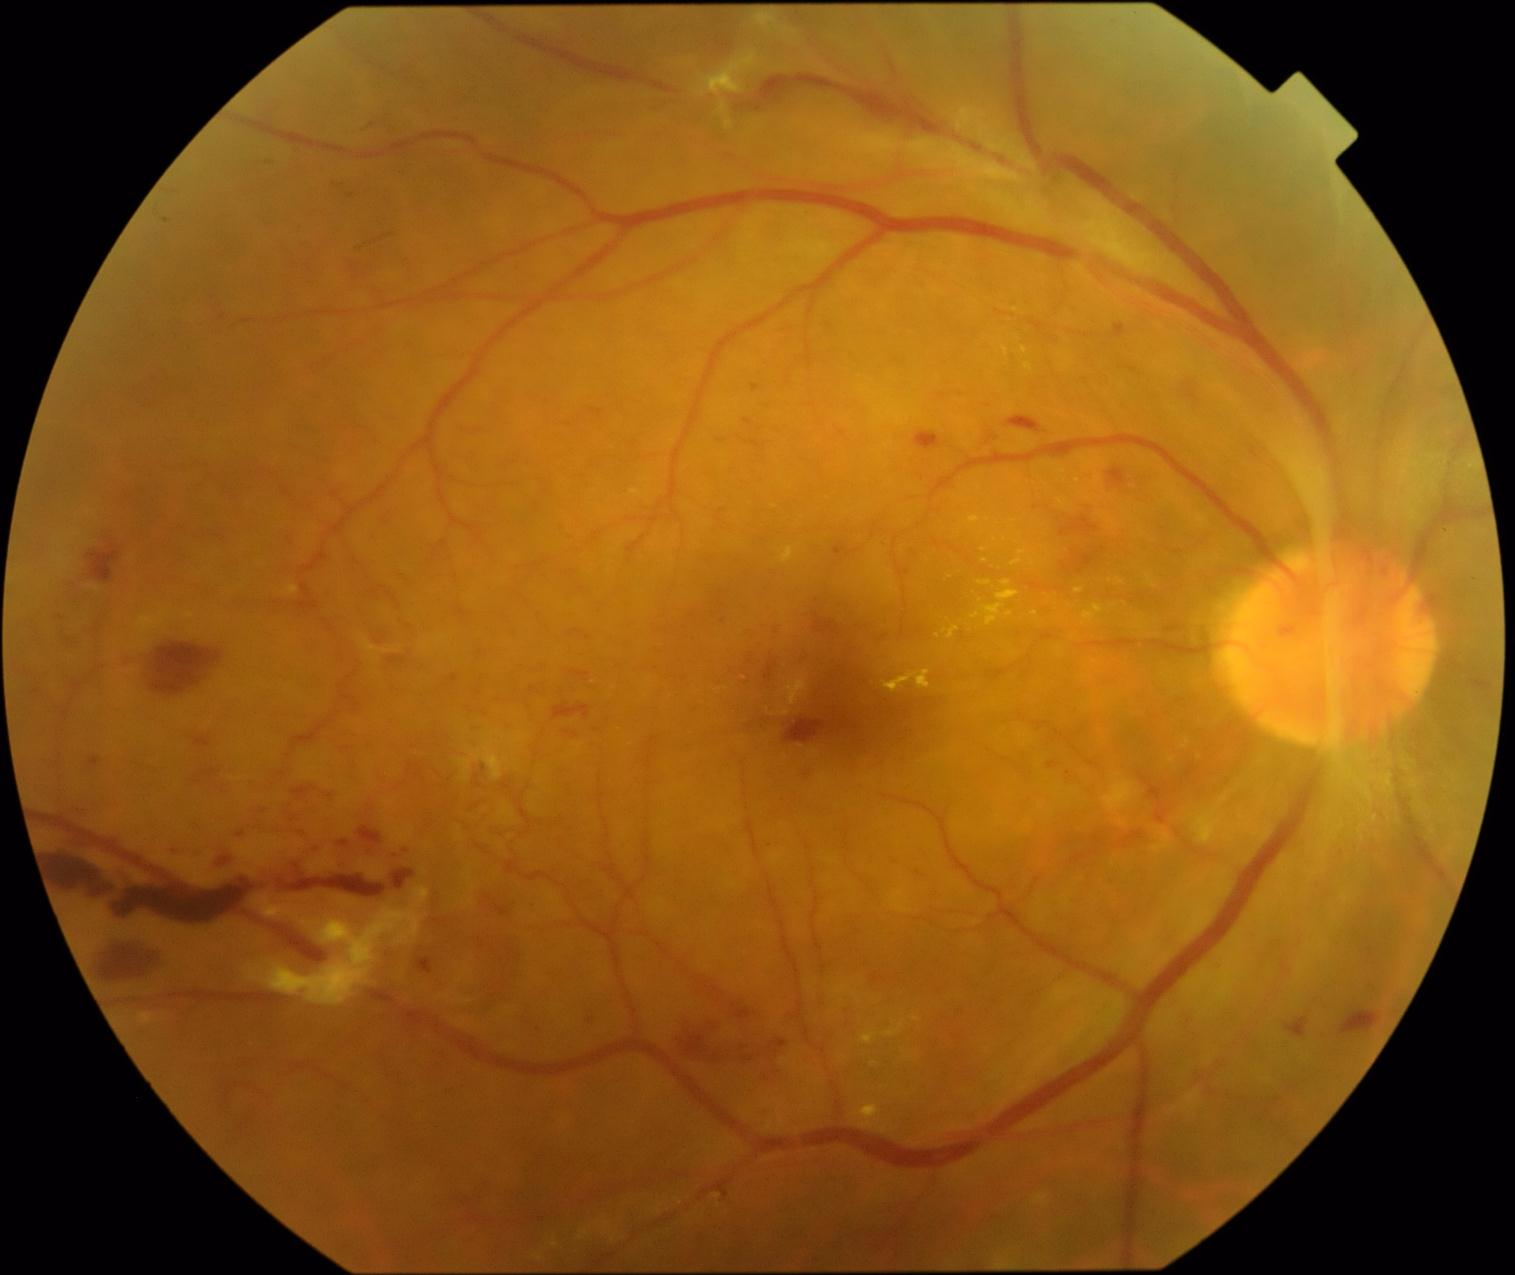
partial: true
dr_grade: 4
dr_grade_name: PDR
lesions:
  he:
    - [x1=554, y1=706, x2=591, y2=720]
    - [x1=812, y1=613, x2=840, y2=635]
    - [x1=1109, y1=470, x2=1128, y2=491]
    - [x1=292, y1=825, x2=311, y2=842]
    - [x1=1060, y1=516, x2=1099, y2=537]
    - [x1=167, y1=848, x2=185, y2=860]
    - [x1=1091, y1=851, x2=1099, y2=857]
    - [x1=386, y1=851, x2=401, y2=863]
    - [x1=339, y1=841, x2=350, y2=848]
    - [x1=870, y1=973, x2=893, y2=991]
    - [x1=278, y1=876, x2=386, y2=900]
    - [x1=786, y1=1011, x2=802, y2=1028]
    - [x1=784, y1=717, x2=833, y2=745]
    - [x1=210, y1=851, x2=237, y2=872]
    - [x1=1091, y1=836, x2=1105, y2=845]
    - [x1=307, y1=845, x2=322, y2=856]
    - [x1=141, y1=641, x2=226, y2=698]